240 x 240 pixels; retinal fundus photograph: 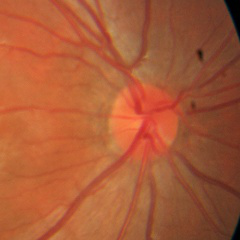
No signs of glaucoma.